45° field of view. Color fundus image — 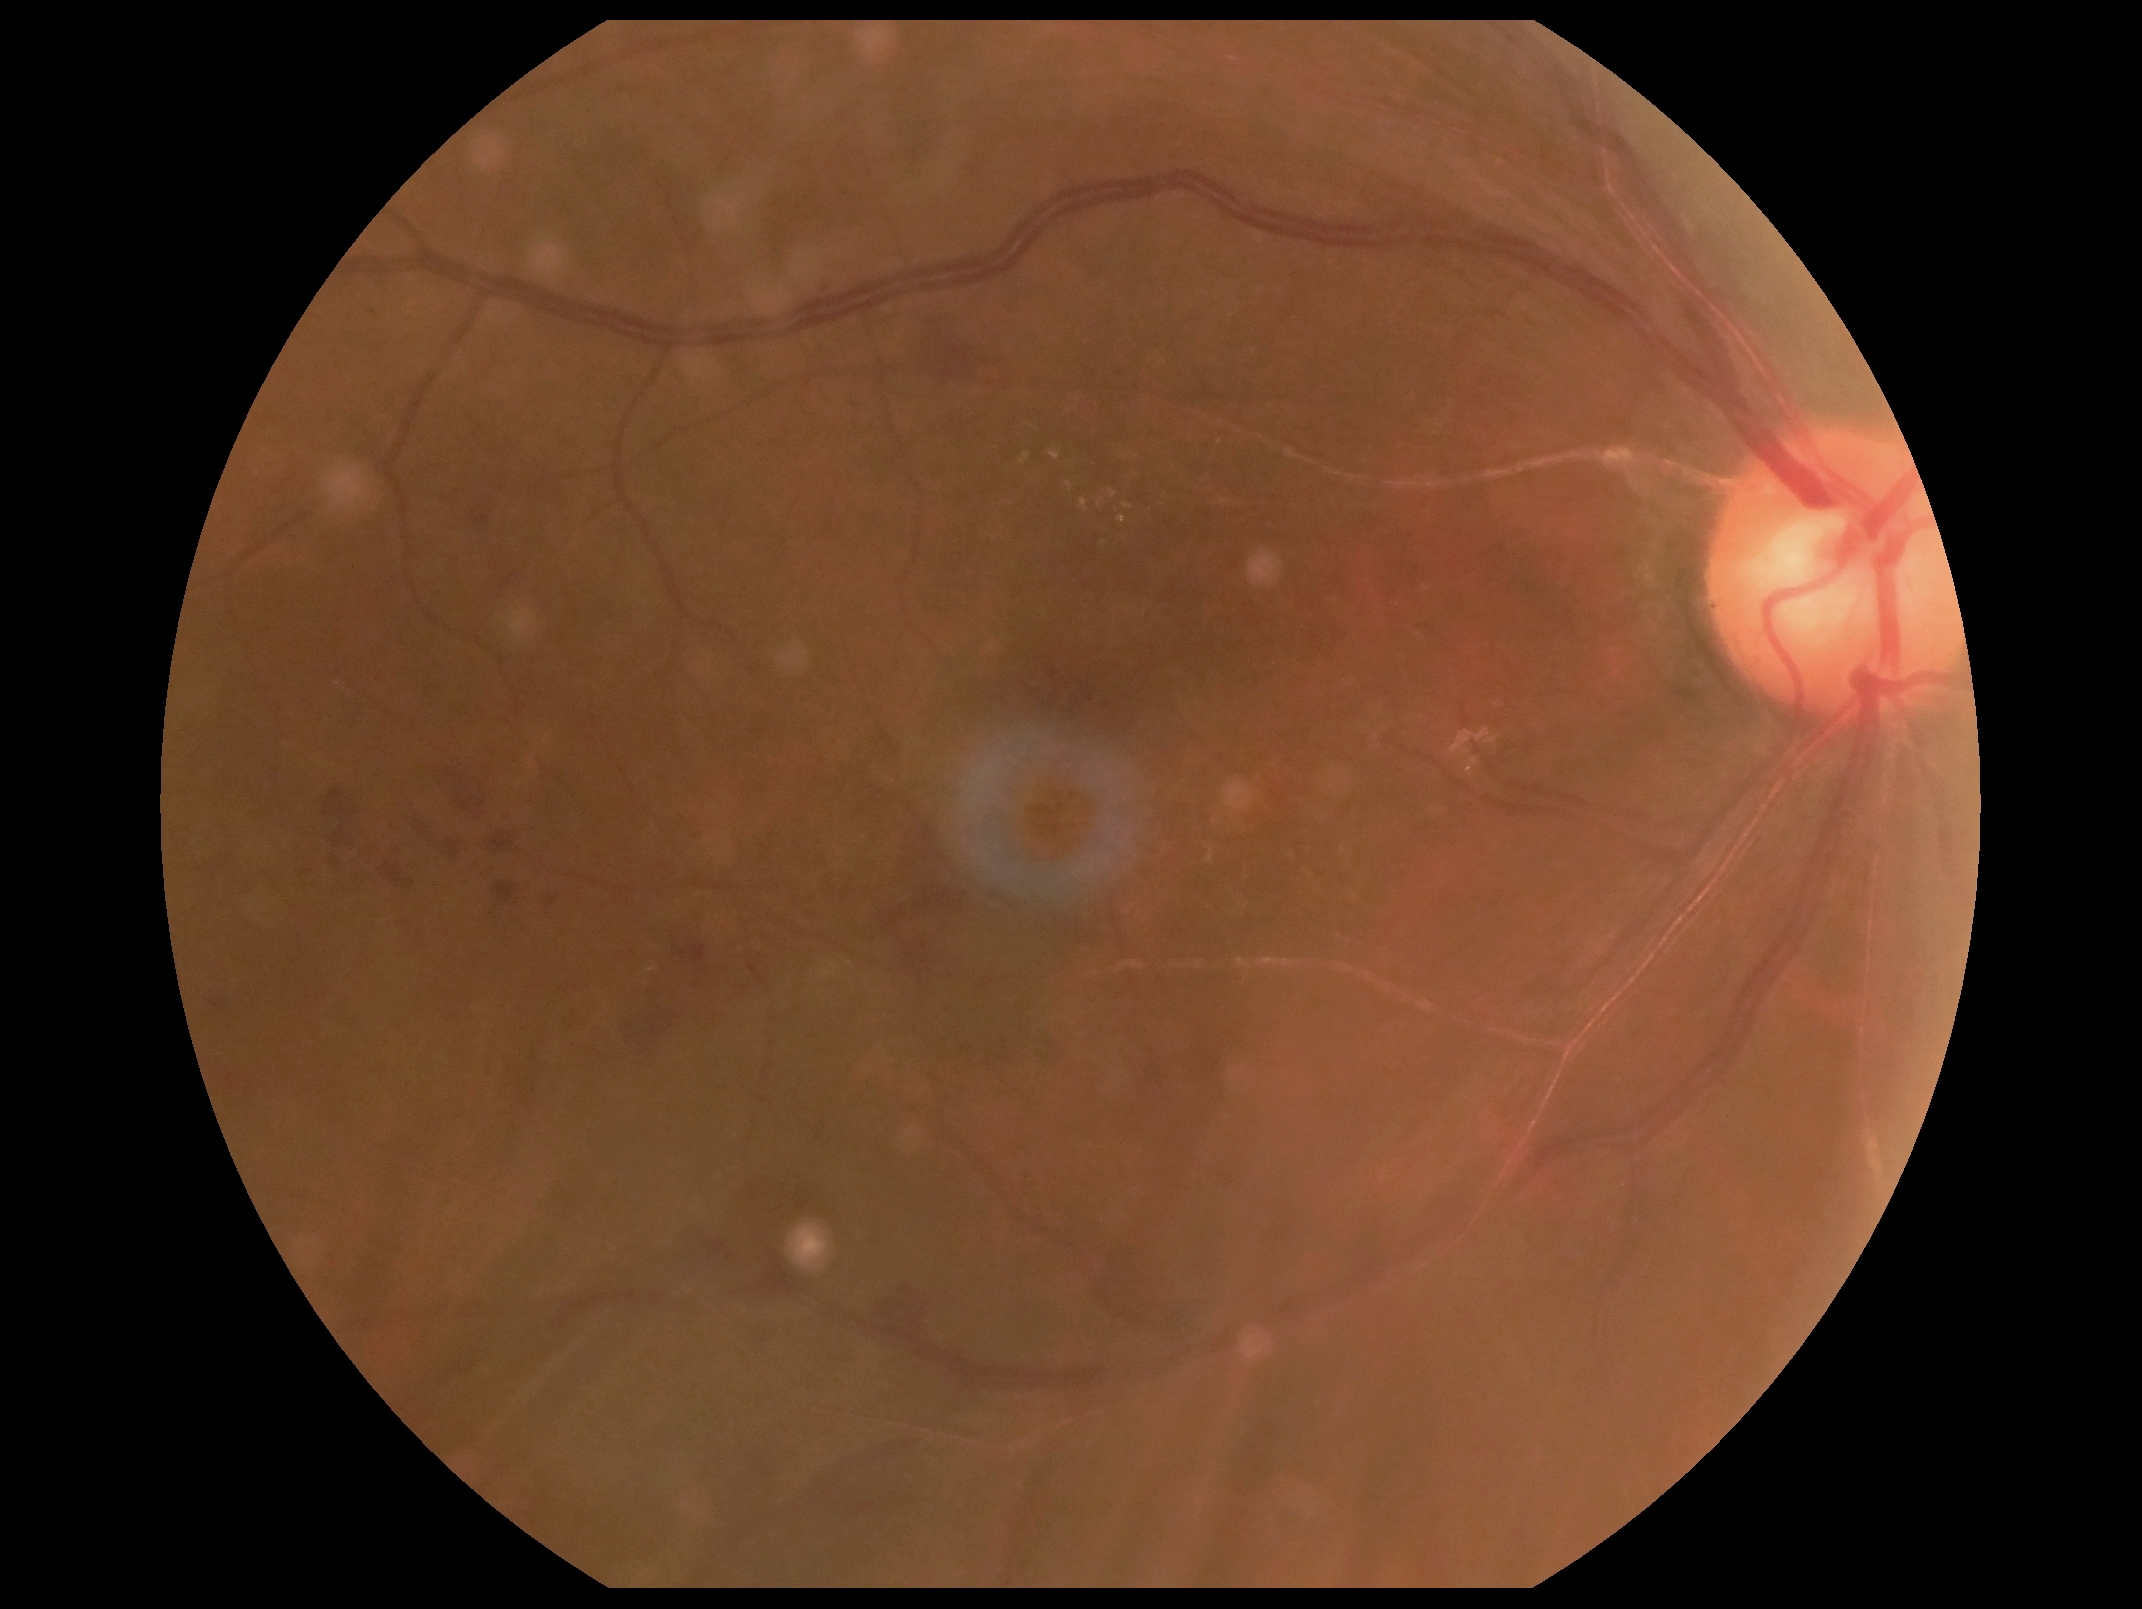 diabetic retinopathy grade: 2/4, DR class: non-proliferative diabetic retinopathy.